848x848, modified Davis classification, CFP: 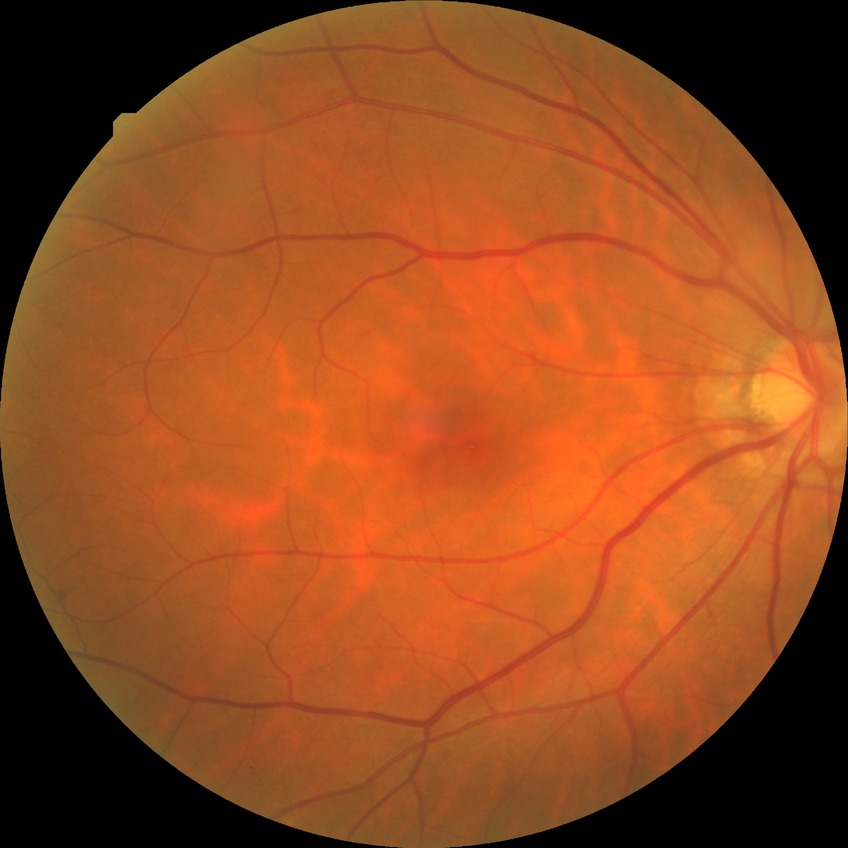

DR stage is SDR.